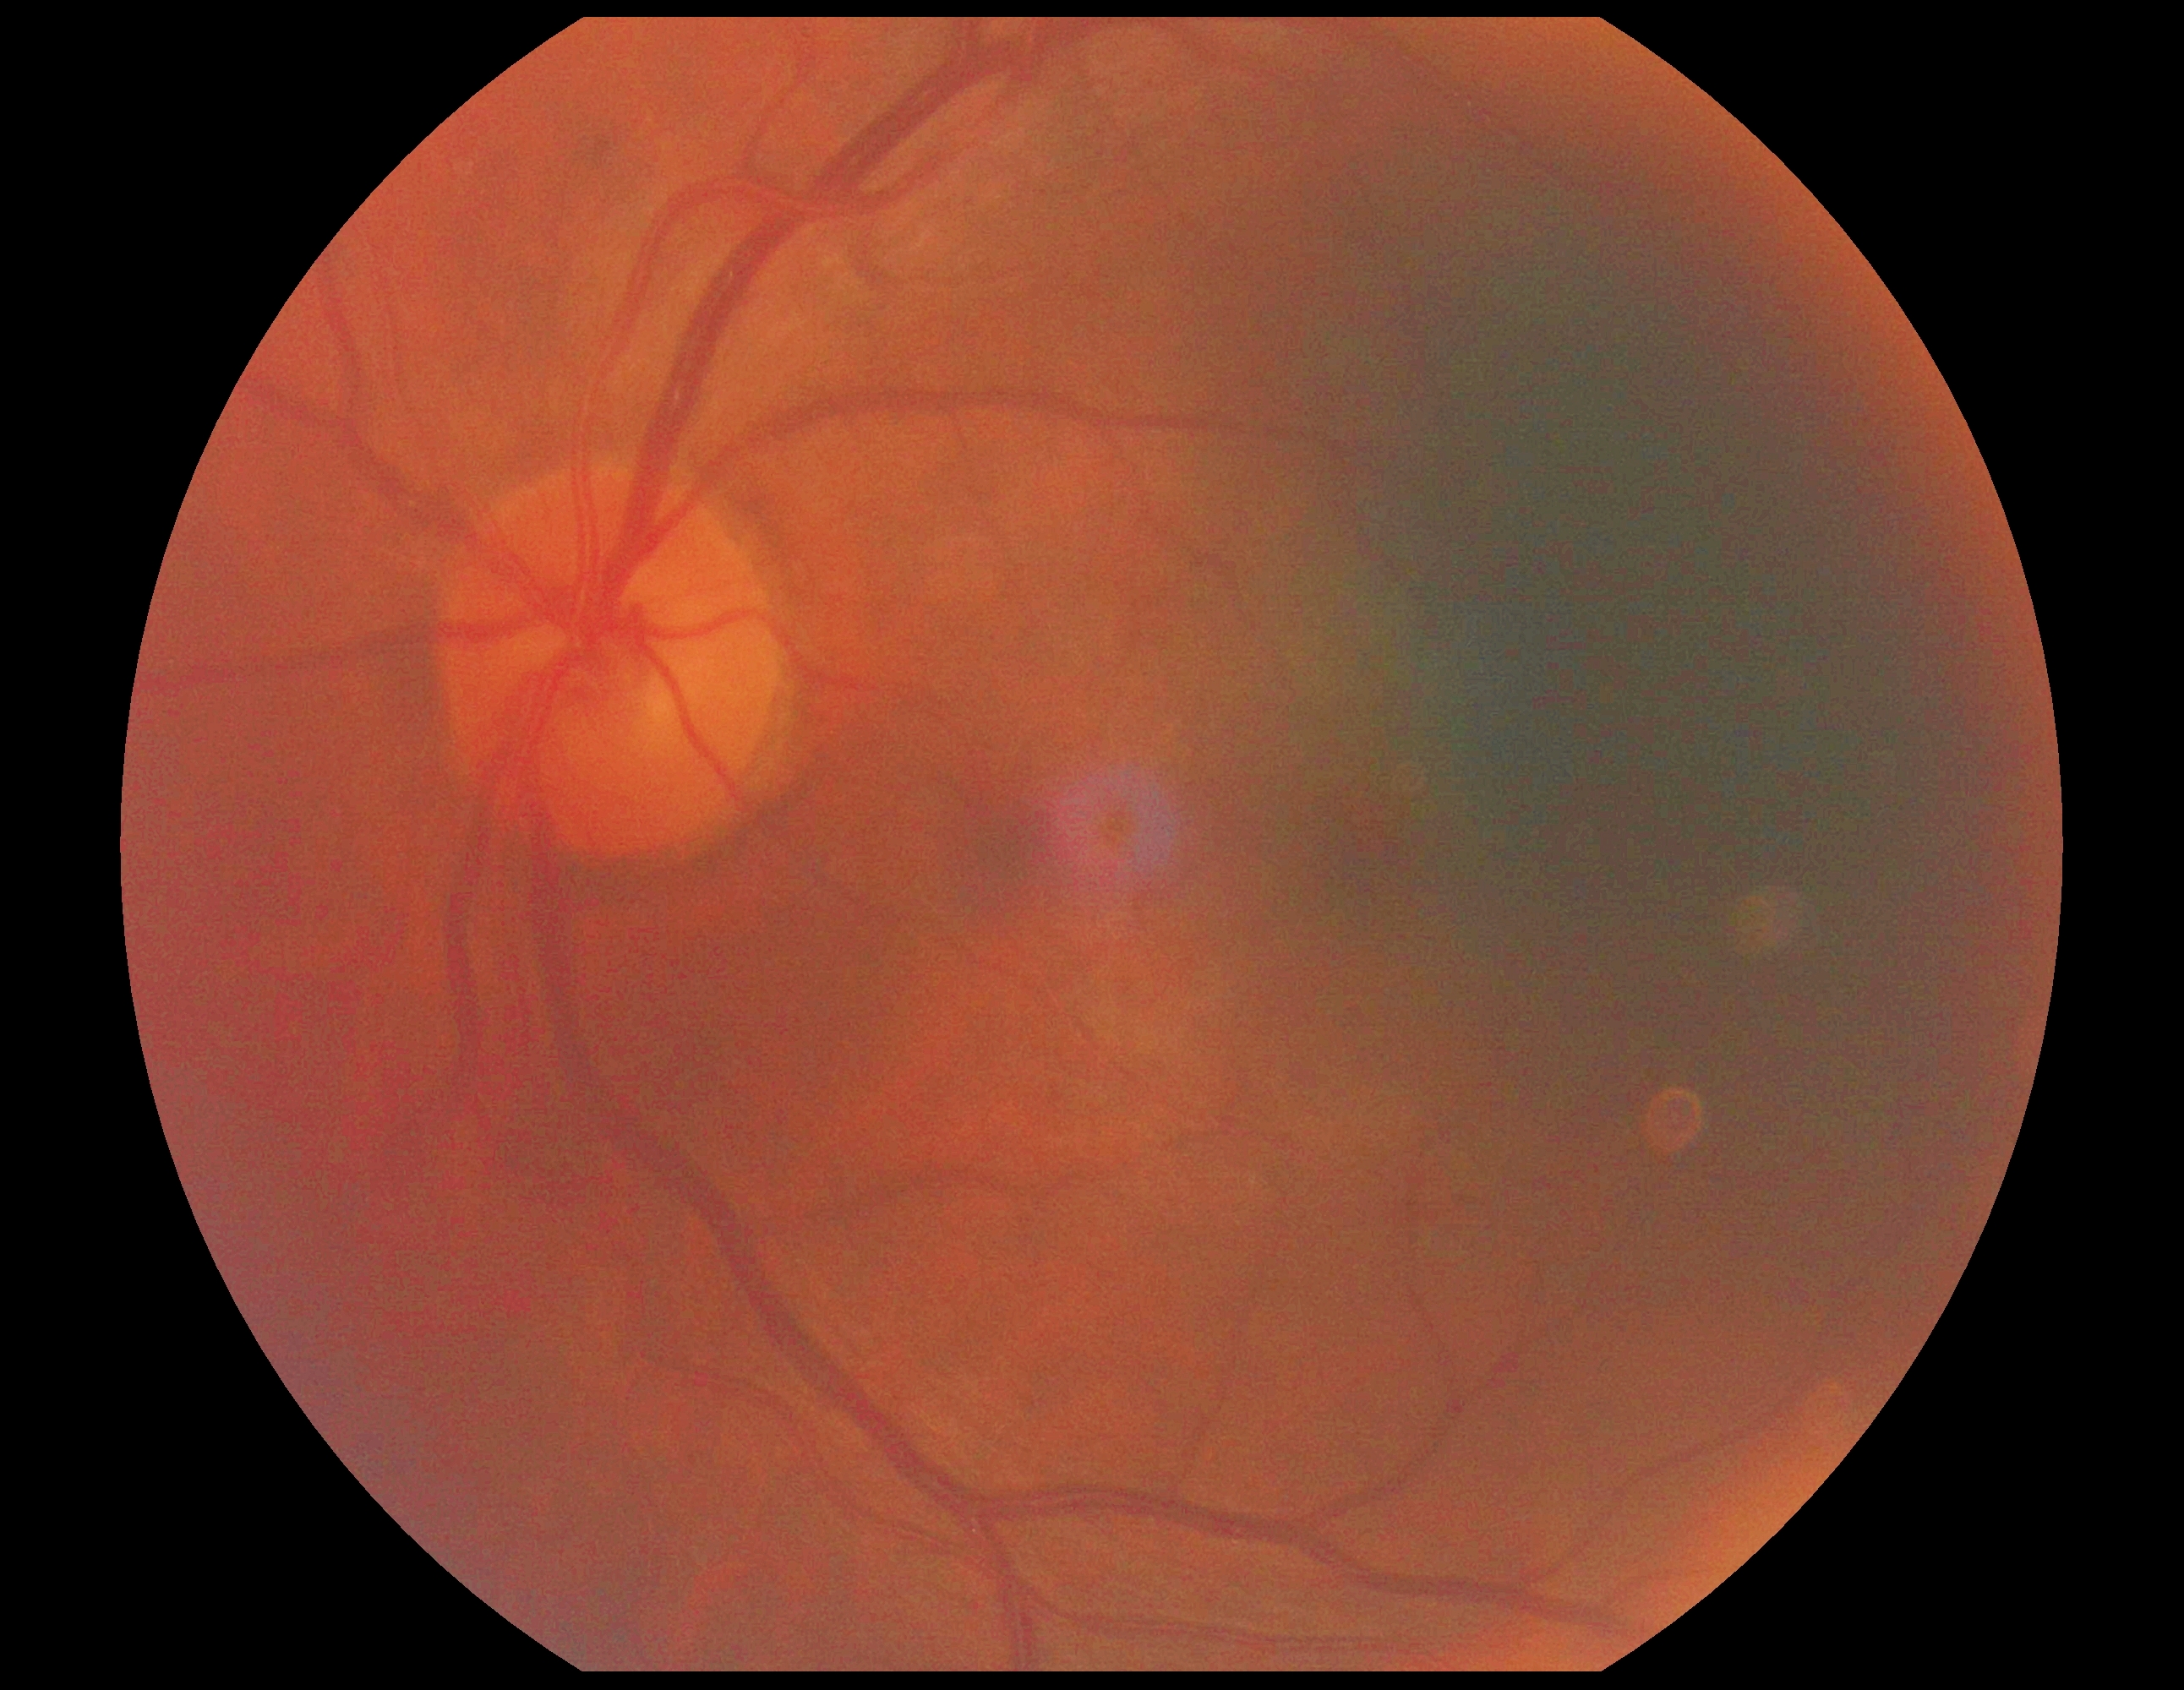

DR grade: 2.